45° FOV · NIDEK AFC-230: 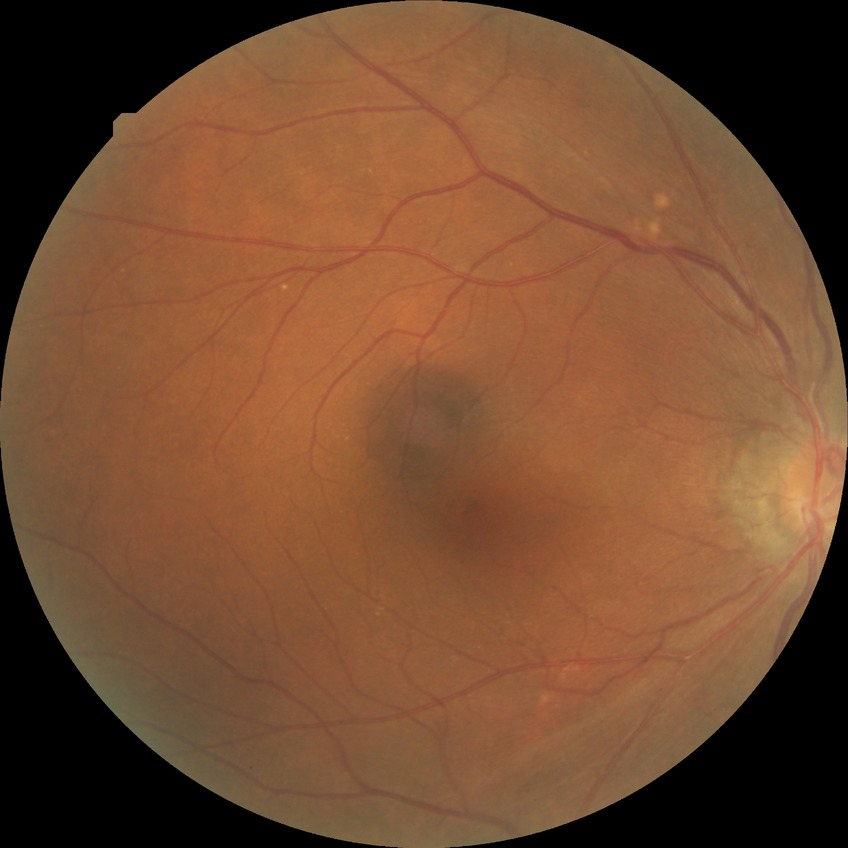 Diabetic retinopathy (DR): no diabetic retinopathy (NDR).